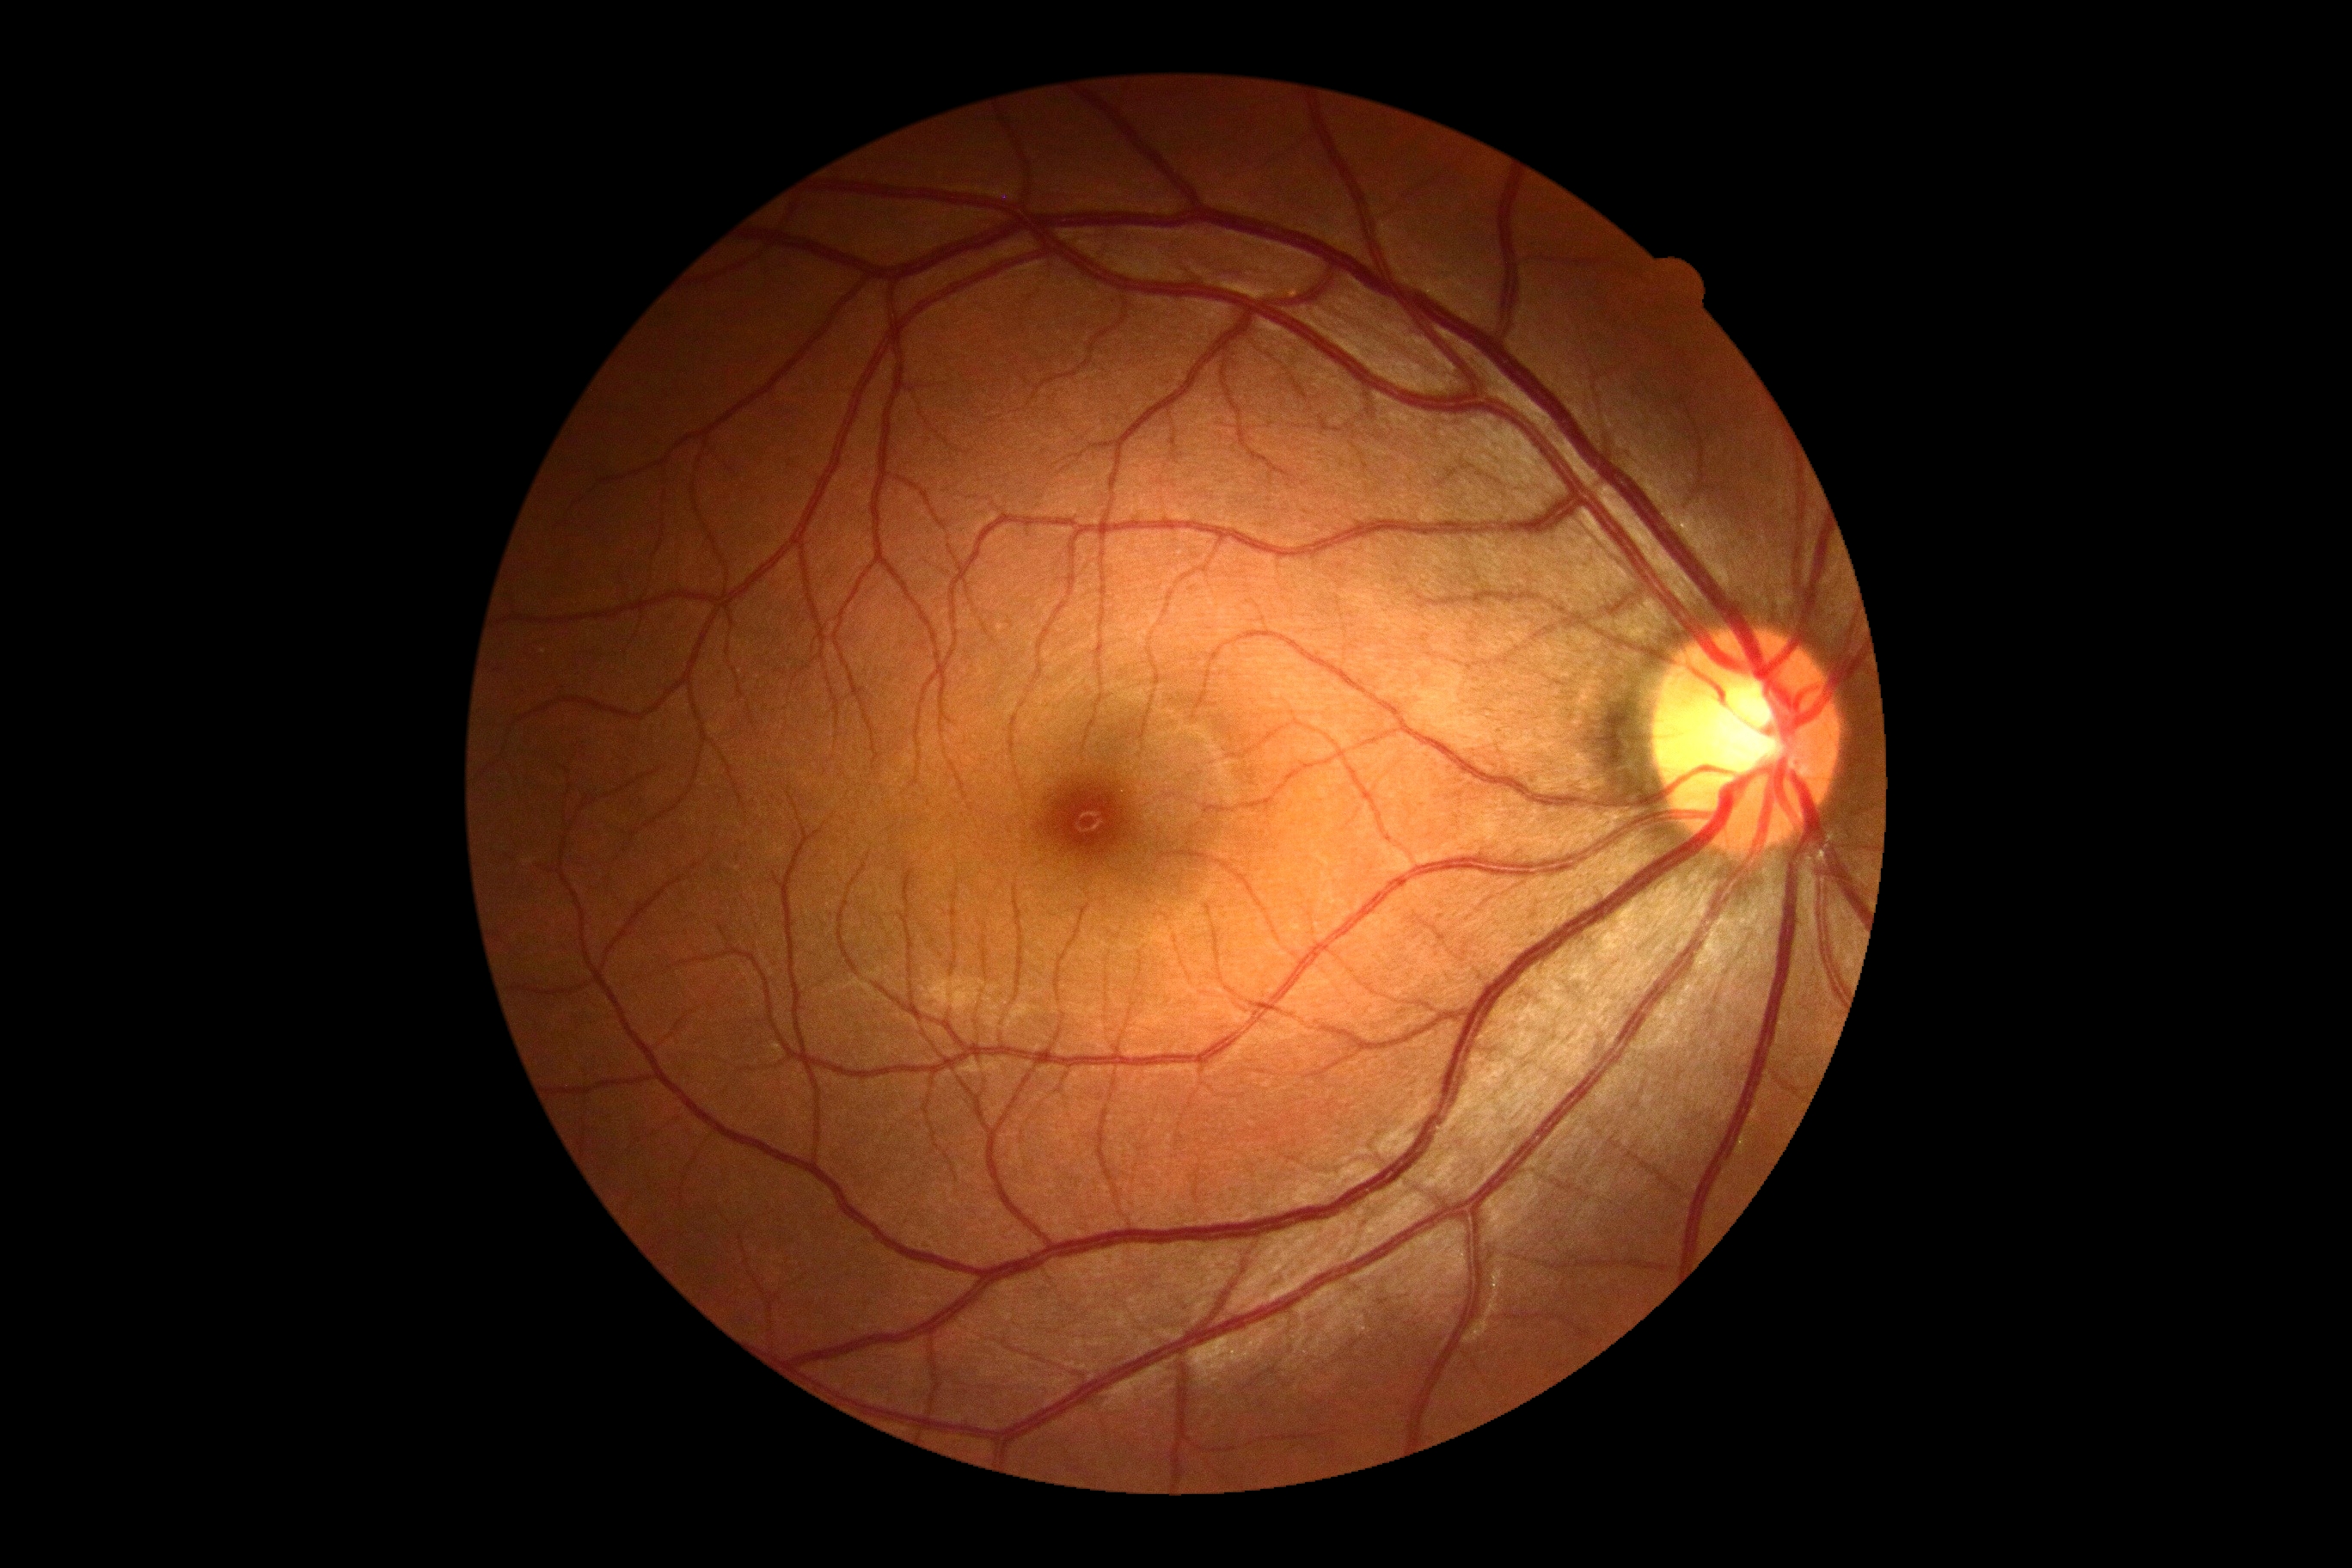
Findings:
* DR impression — no apparent DR
* DR grade — 0 (no apparent retinopathy)